Pupil-dilated.
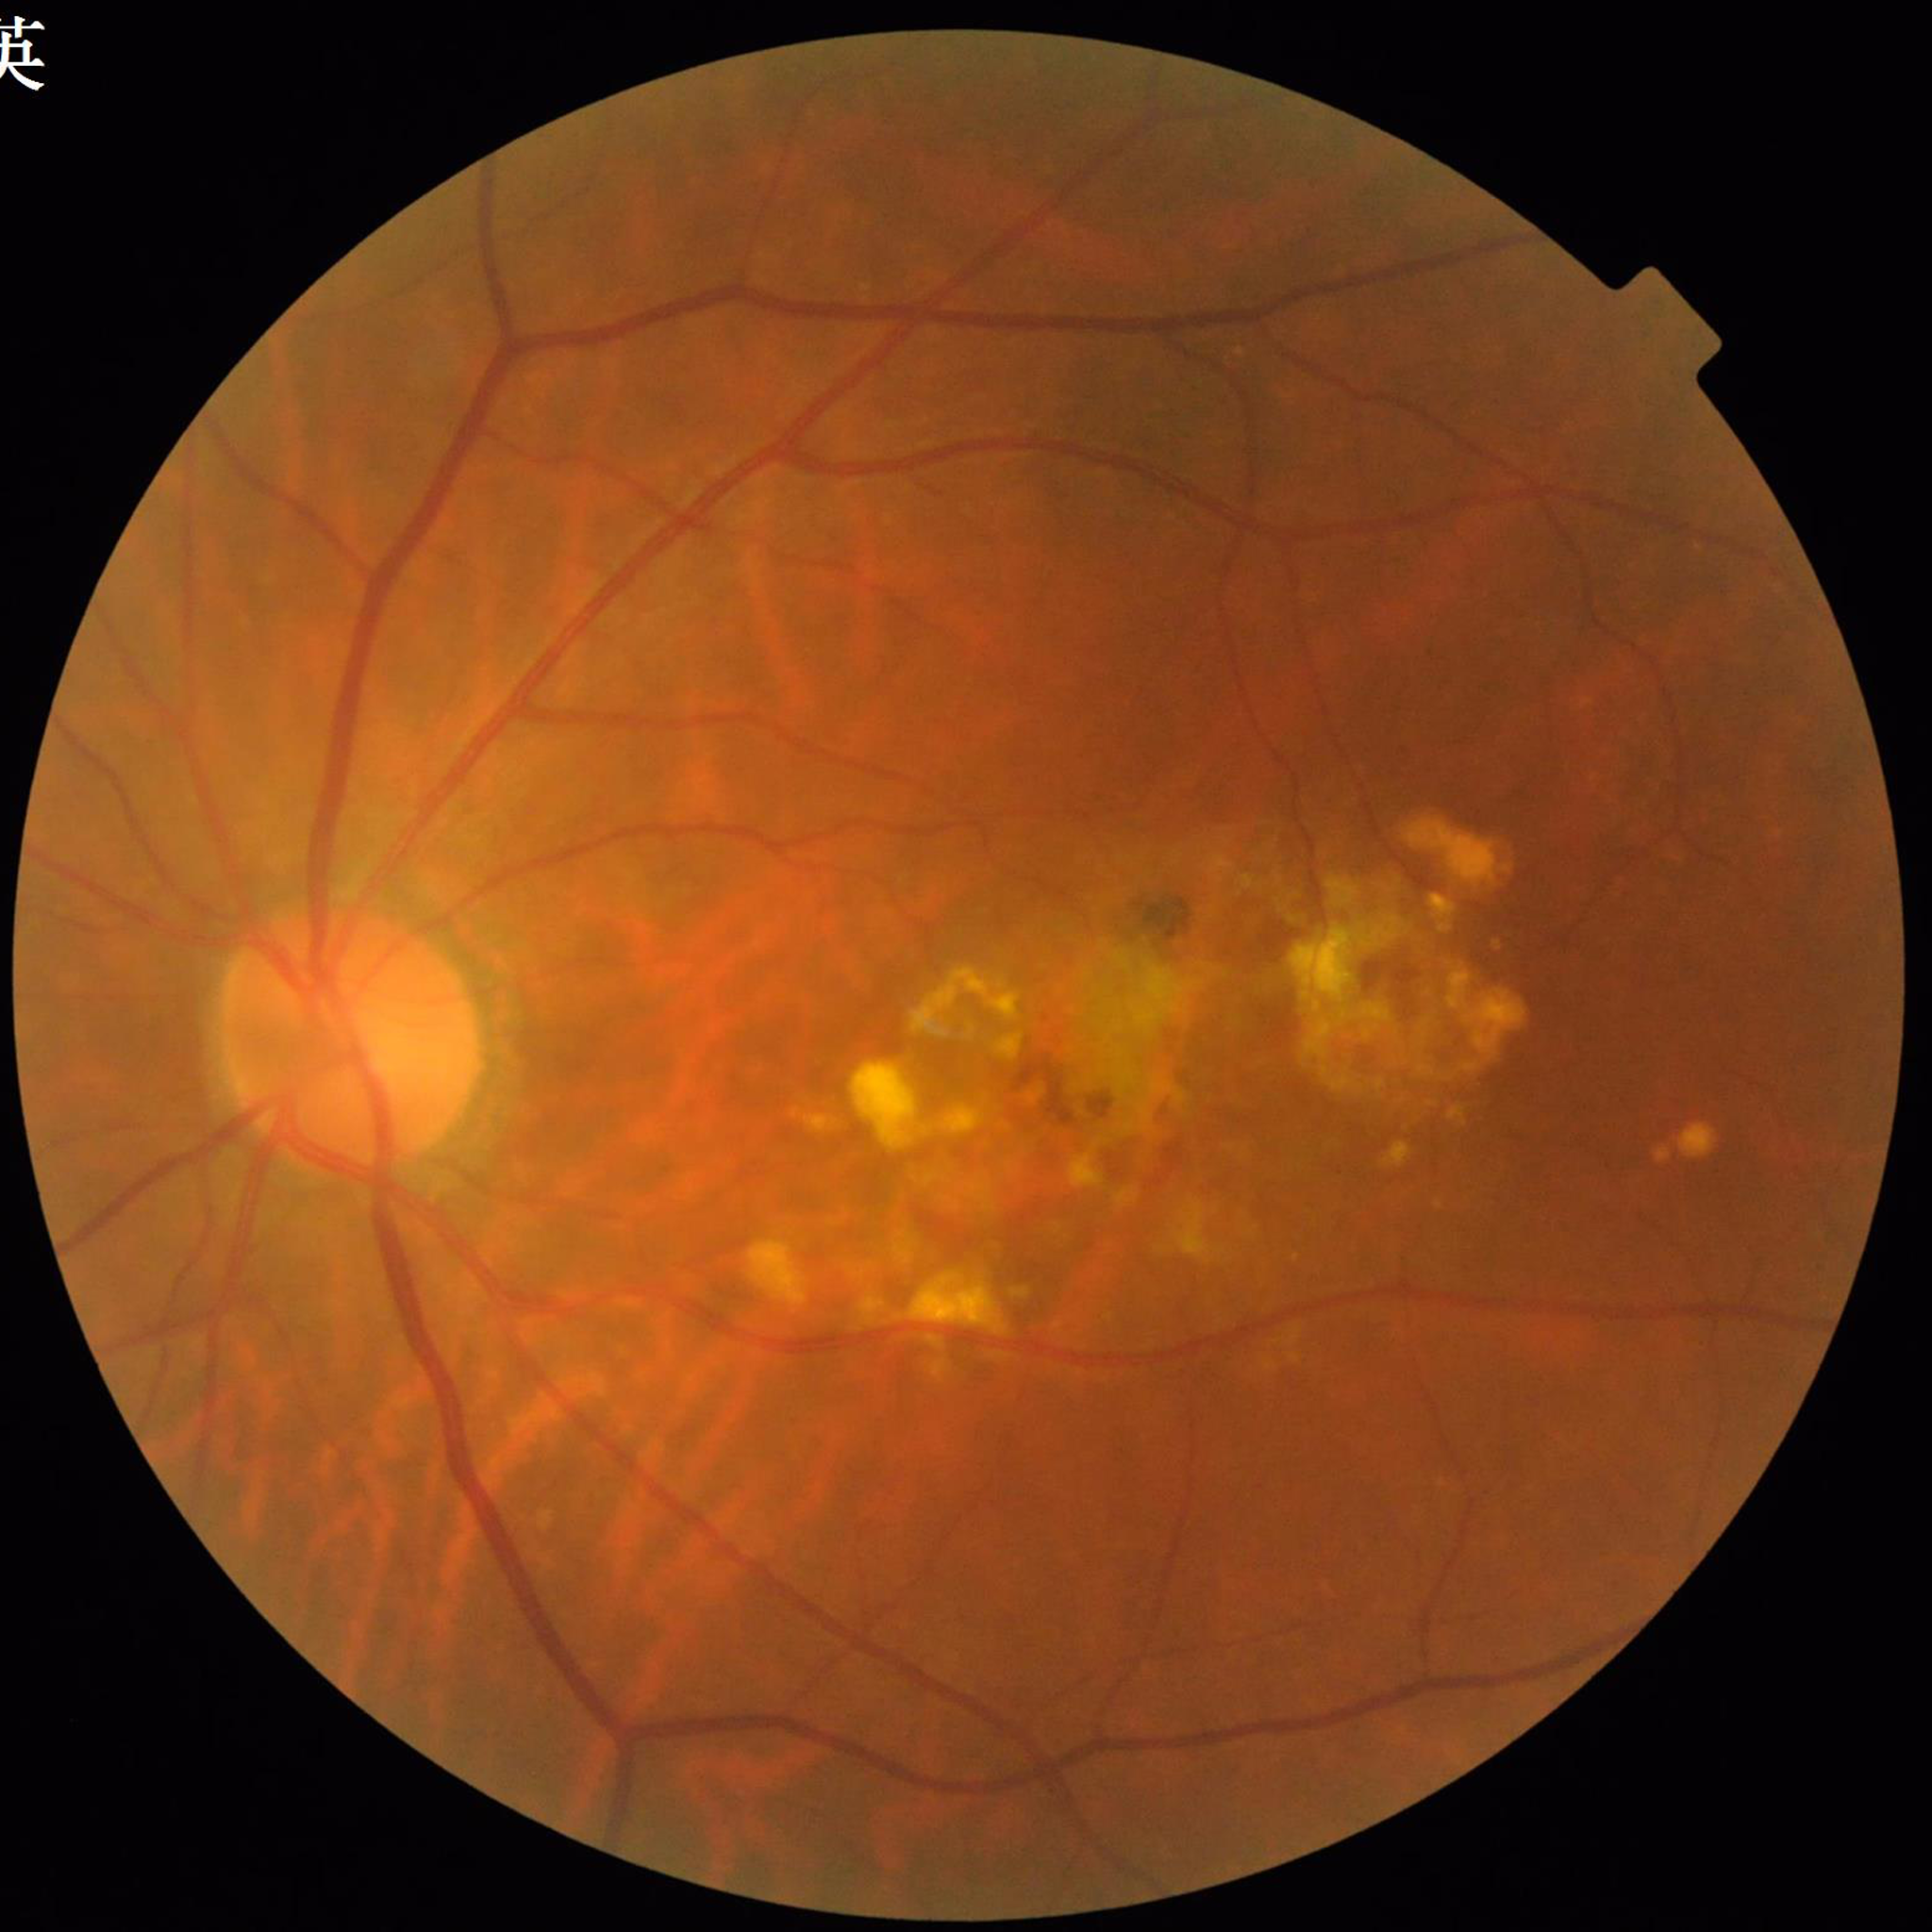

From a patient with age-related macular degeneration.